CFP, 2102x1736: 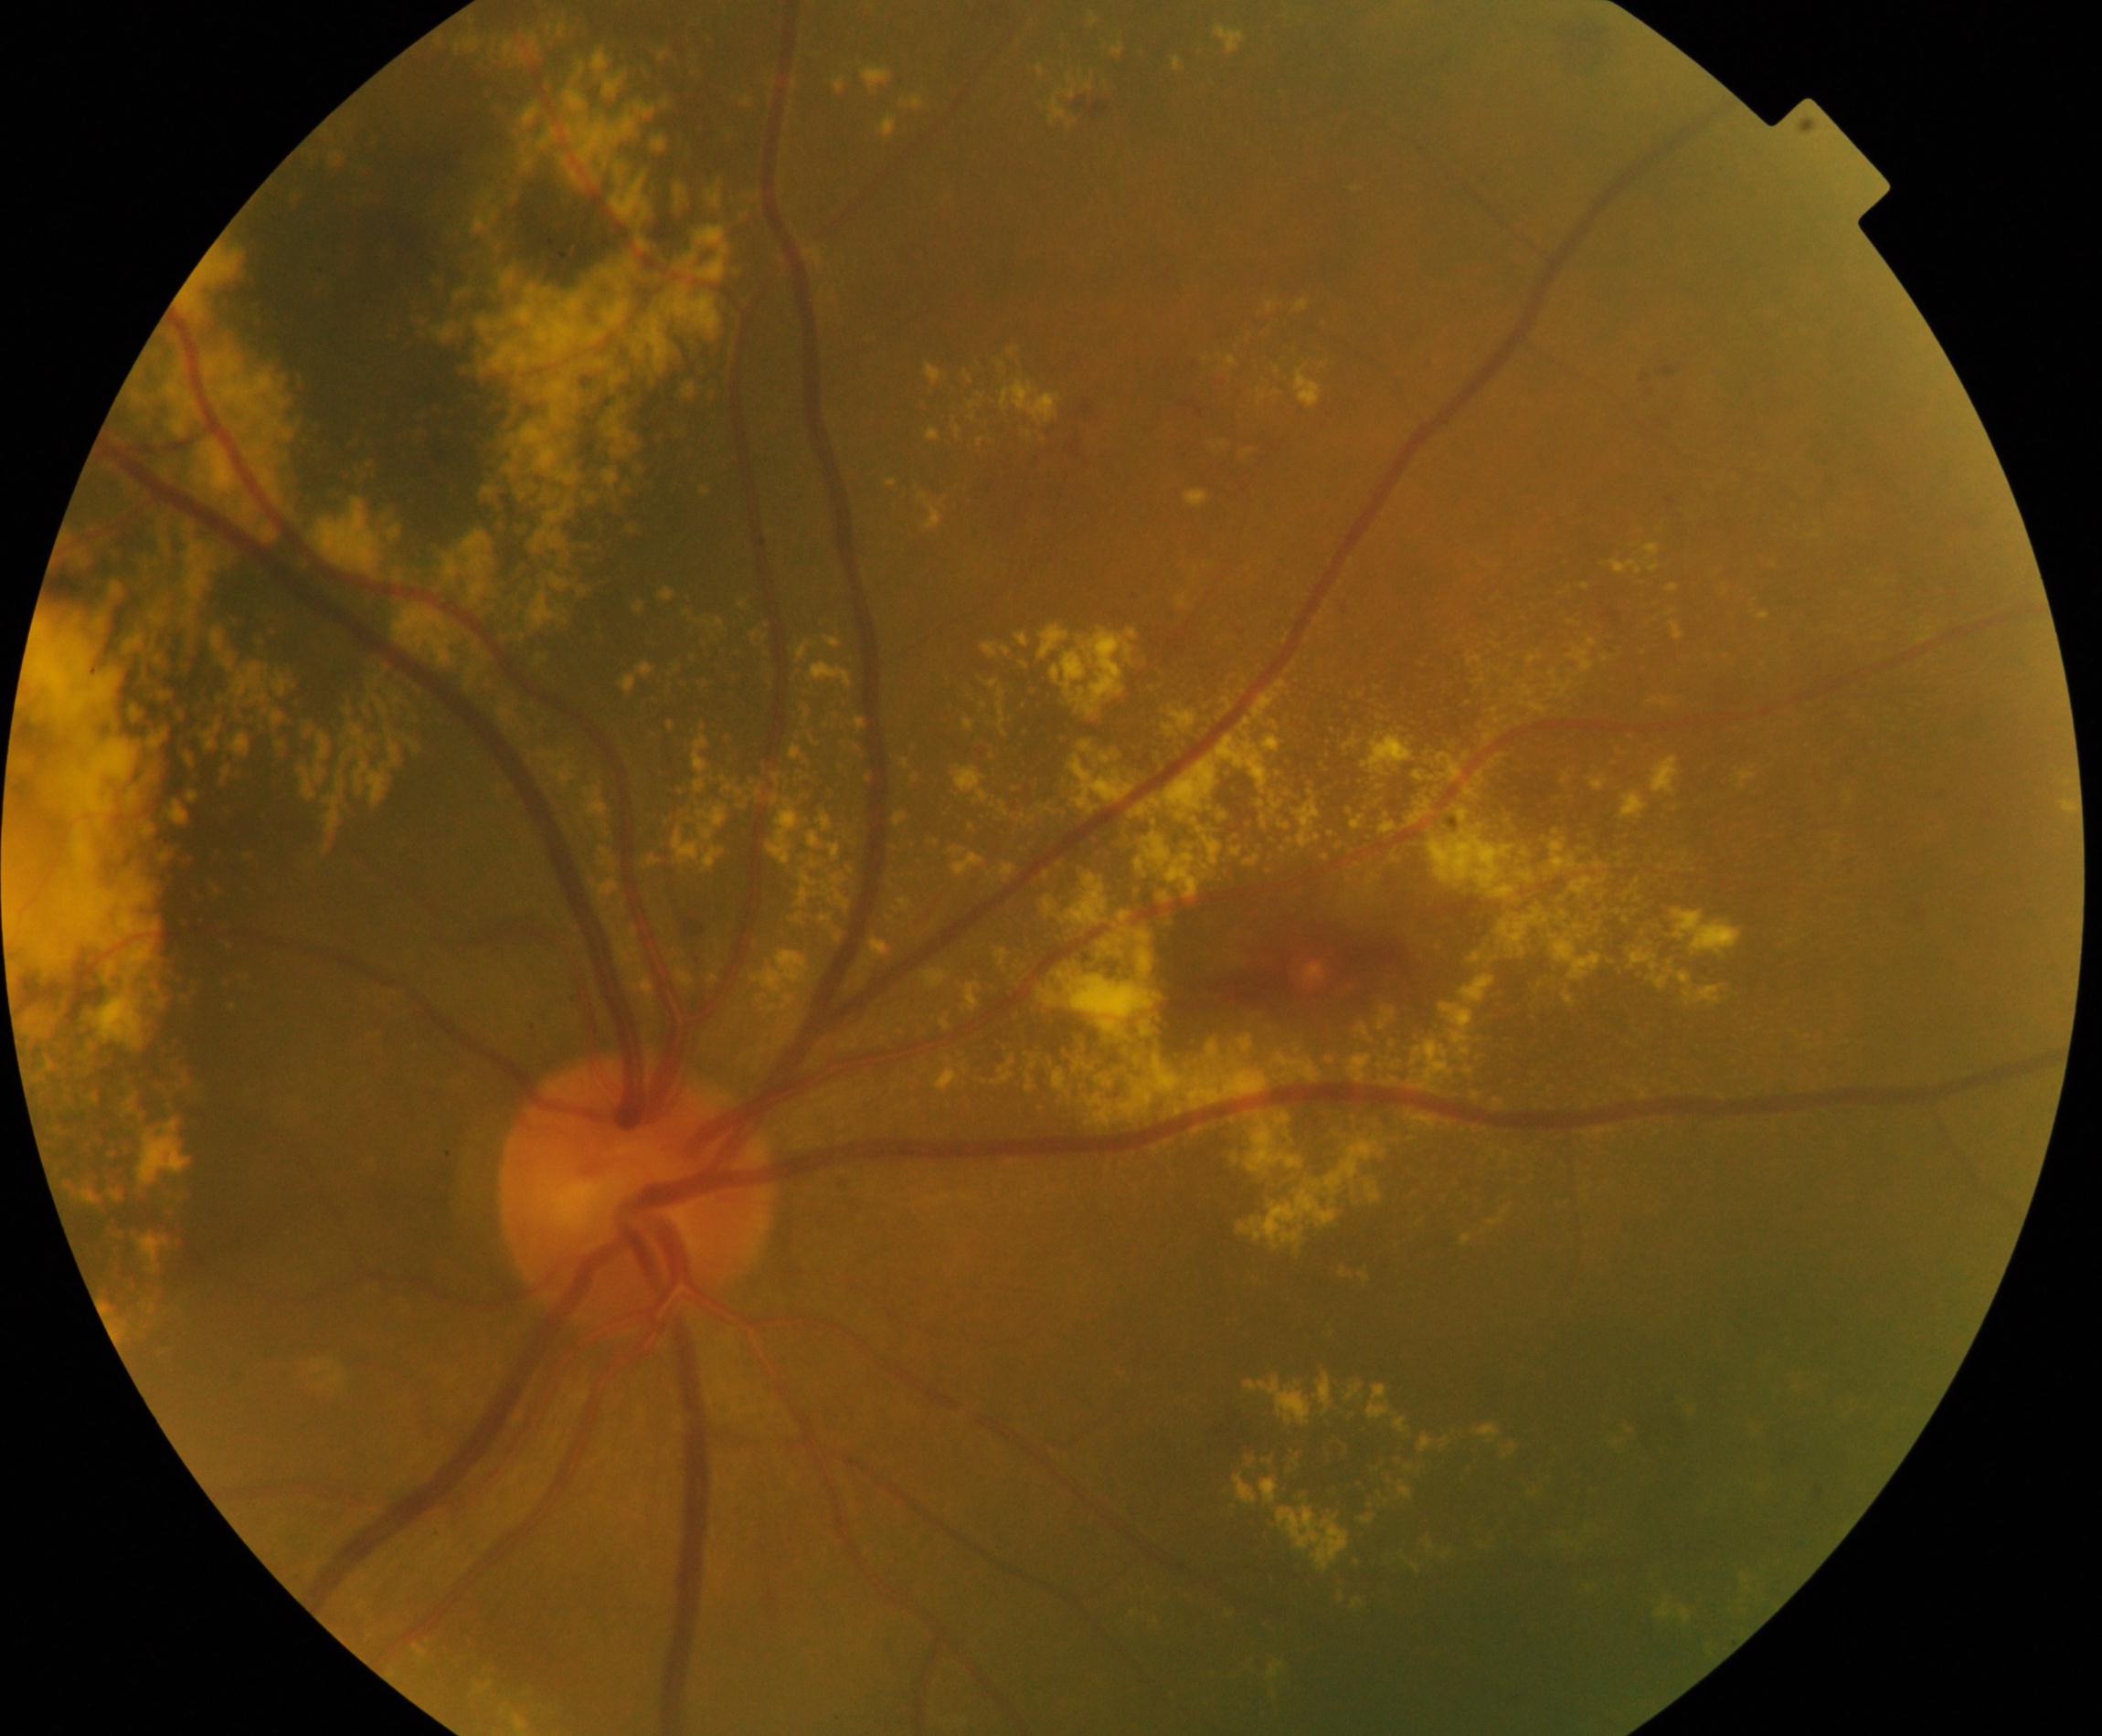
The image shows massive hard exudates.